Color fundus photograph.
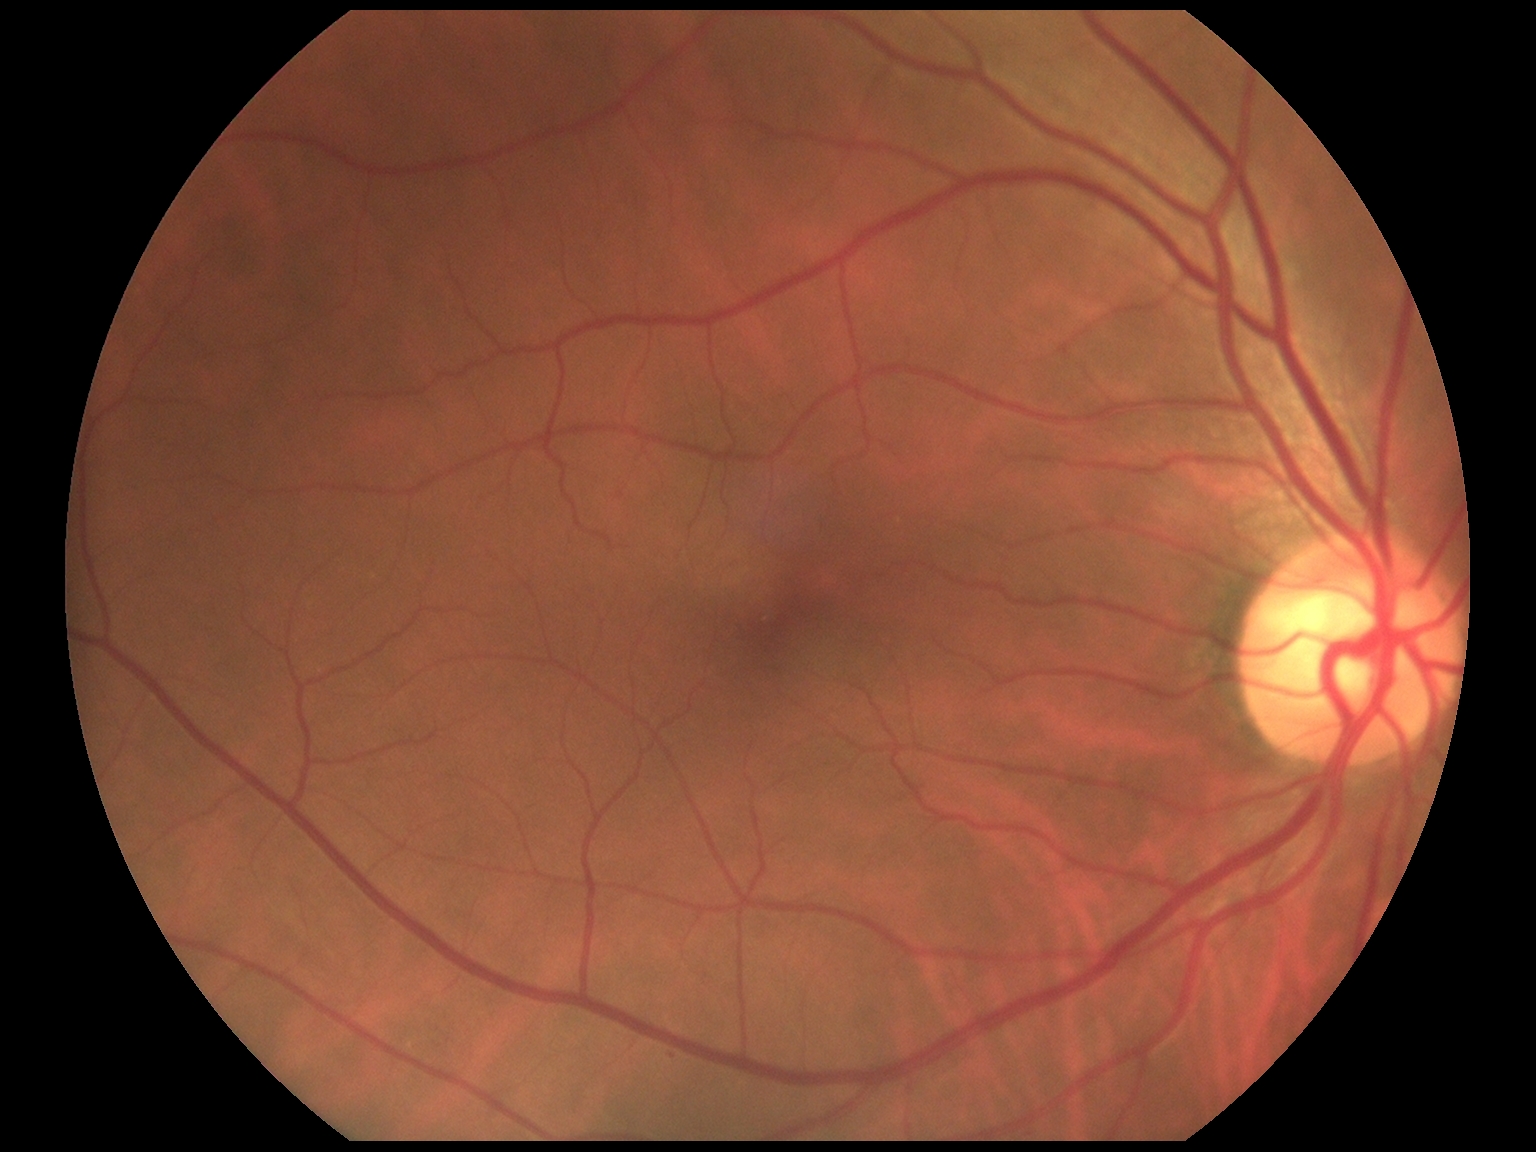 DR severity: no apparent diabetic retinopathy (grade 0).